1240x1240 · pediatric wide-field fundus photograph — 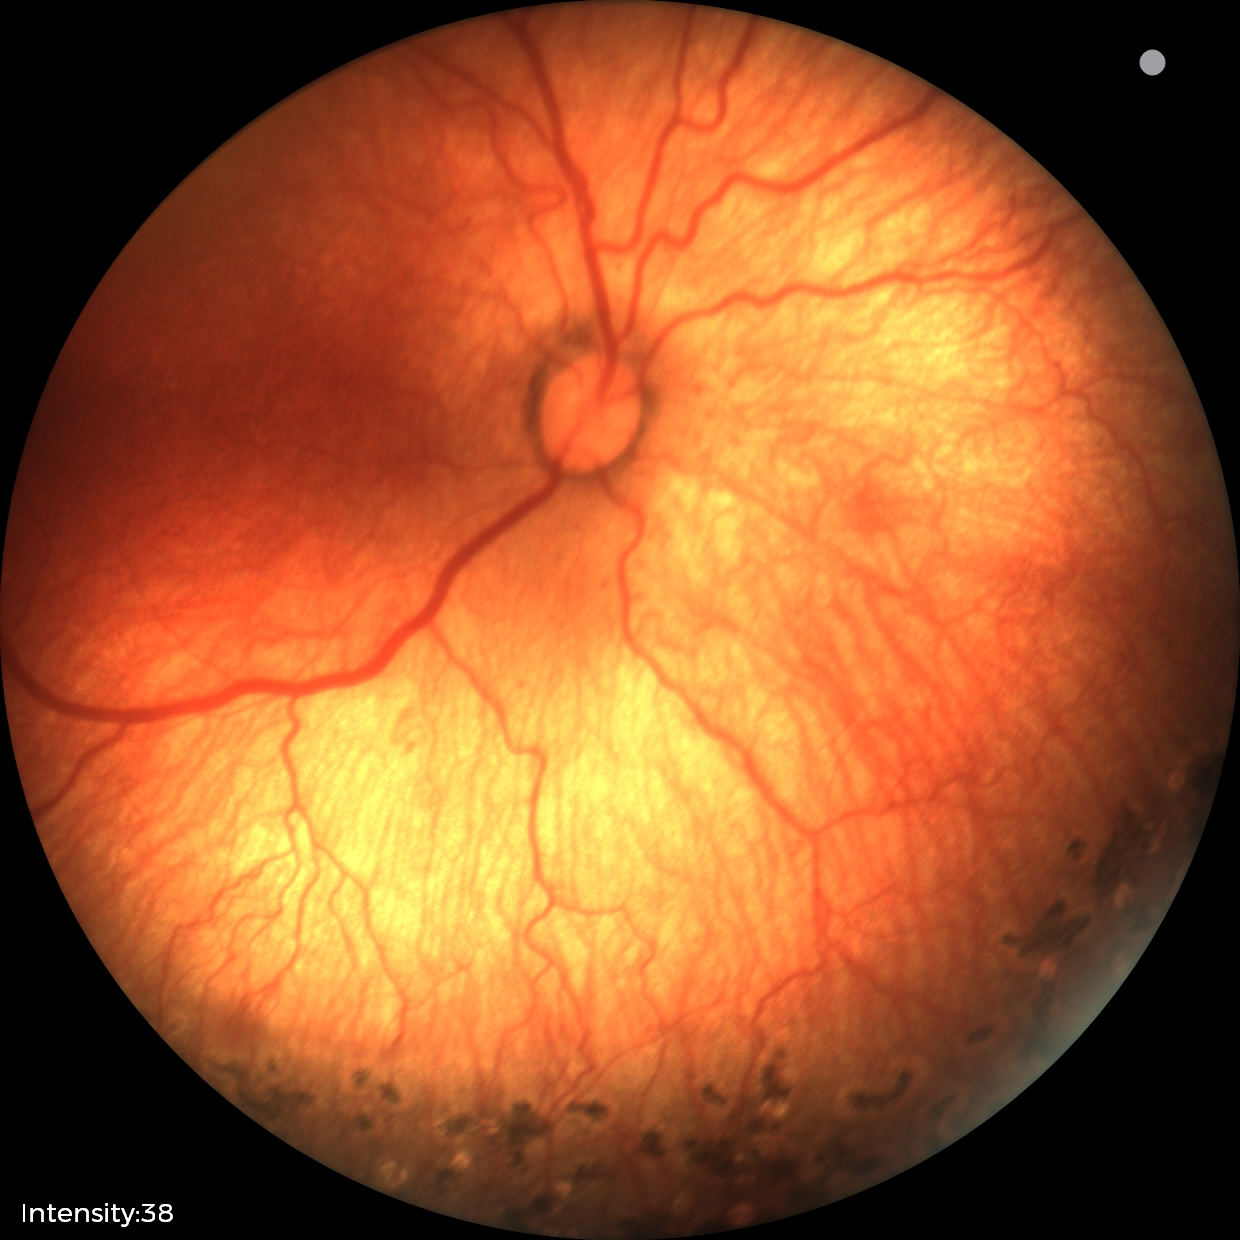
Finding: status post ROP, plus form: absent.